1932 by 1932 pixels: 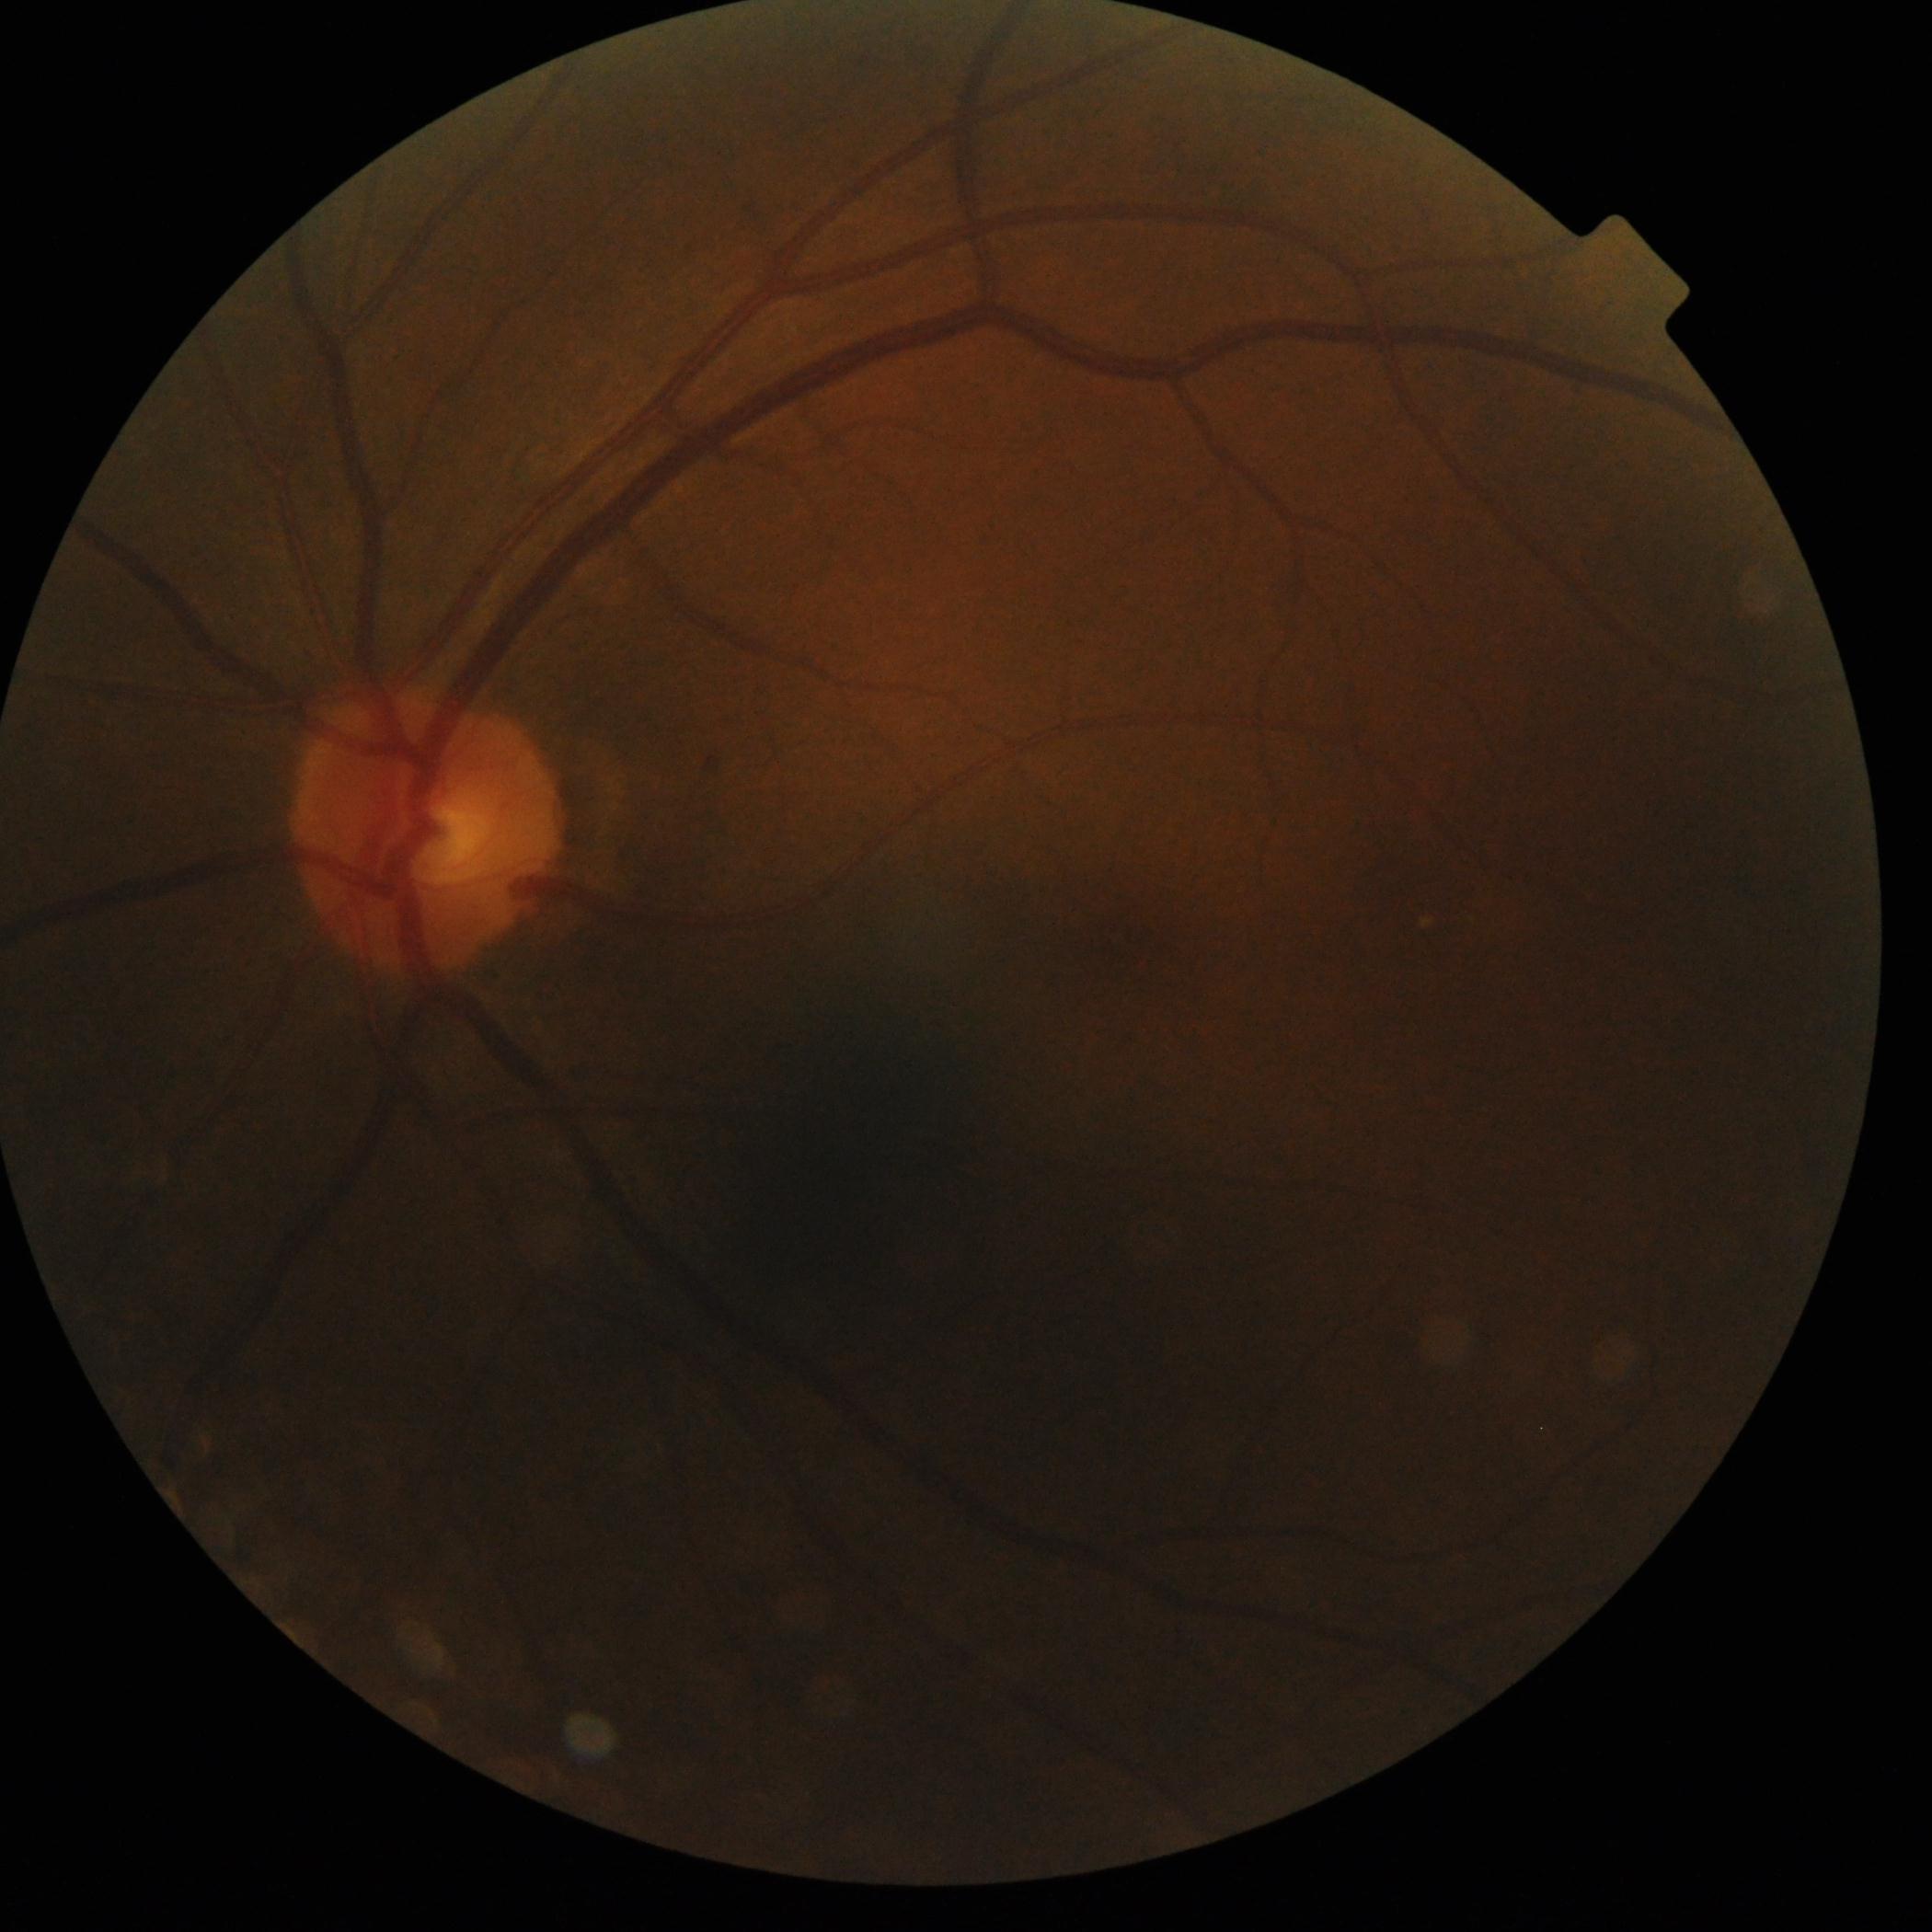
Diabetic retinopathy severity is no apparent diabetic retinopathy (grade 0). No signs of diabetic retinopathy.